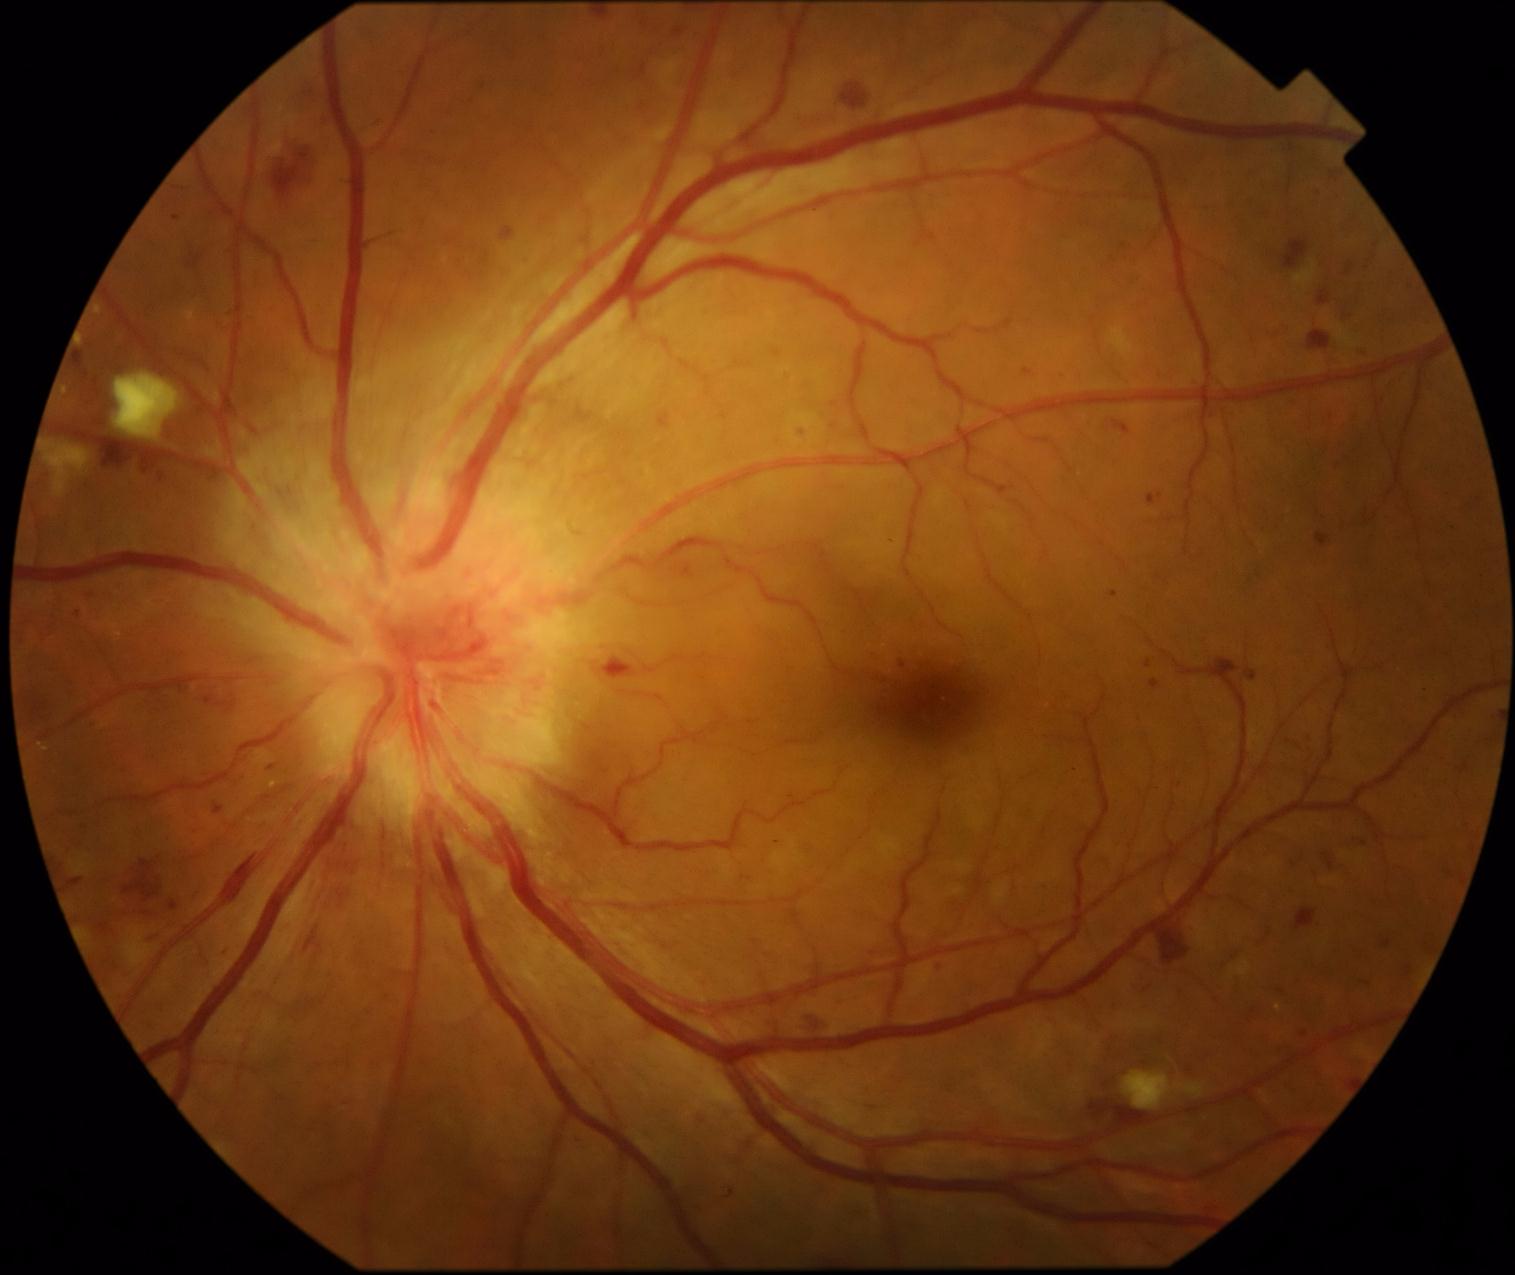
Diabetic retinopathy (DR) is 2/4.